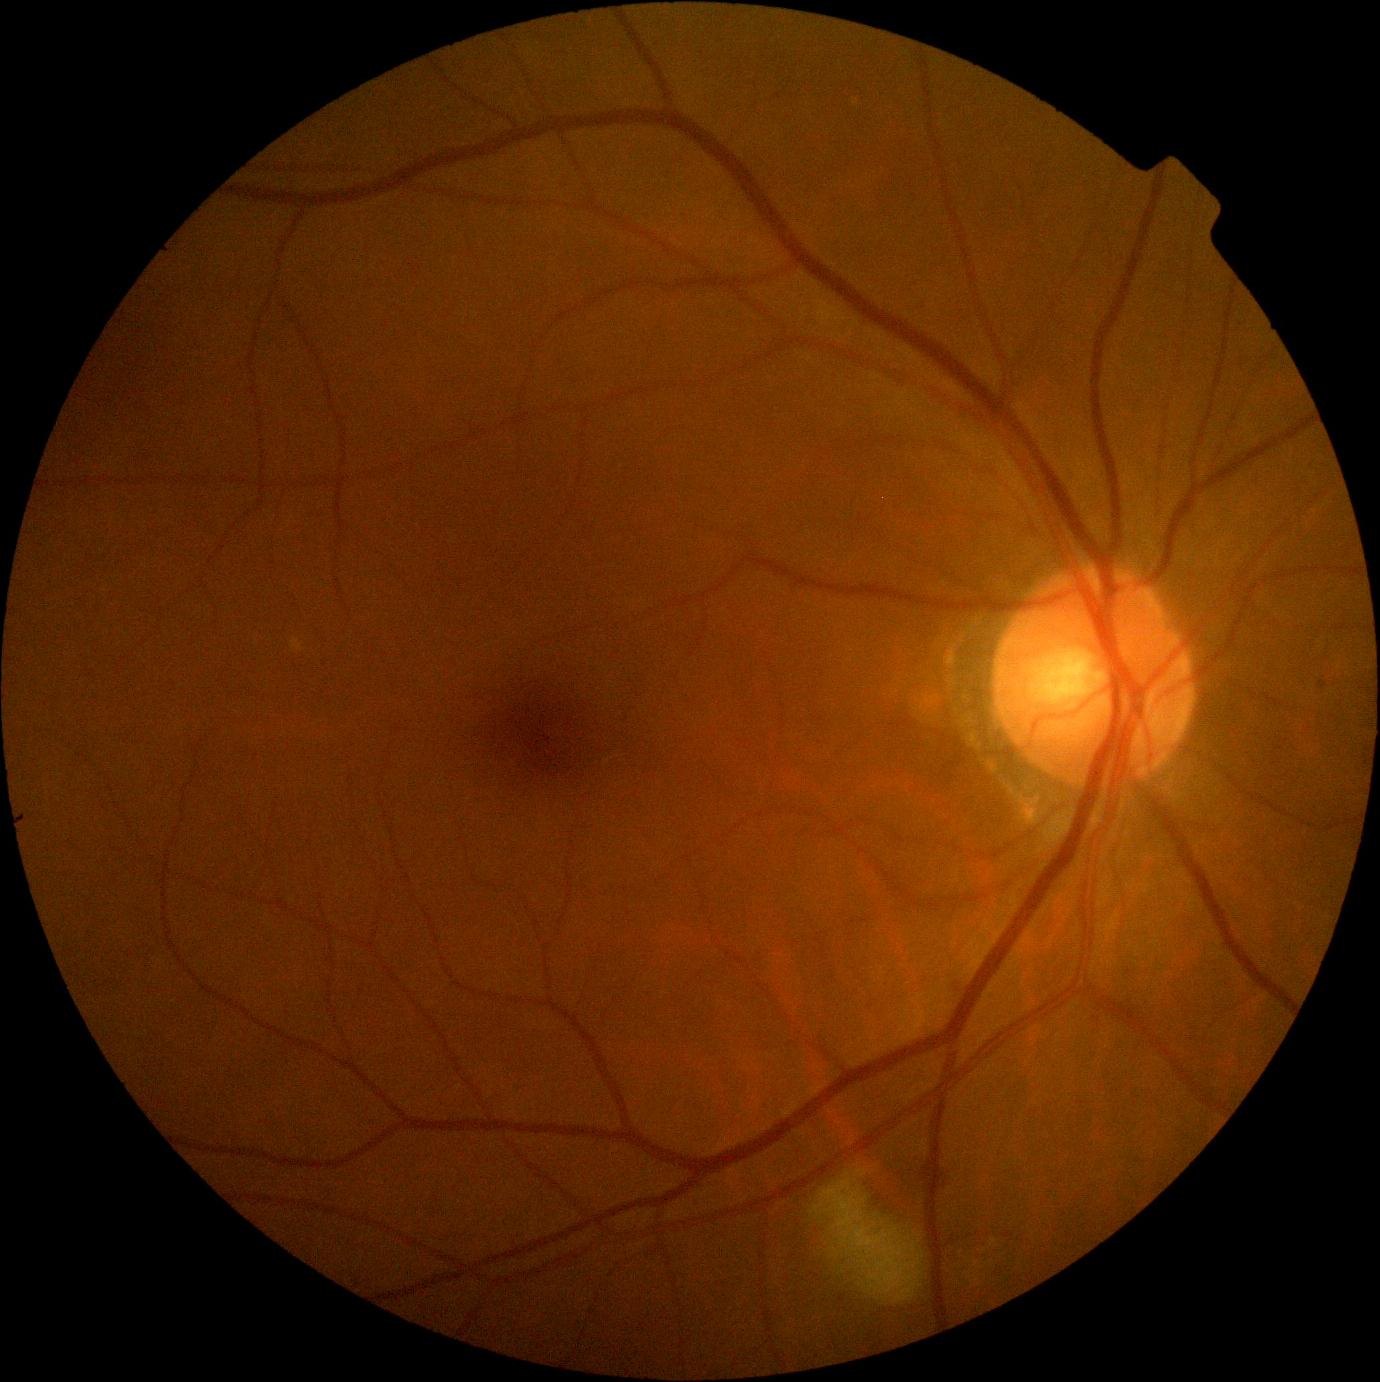 Findings:
* DR grade — moderate NPDR (2)